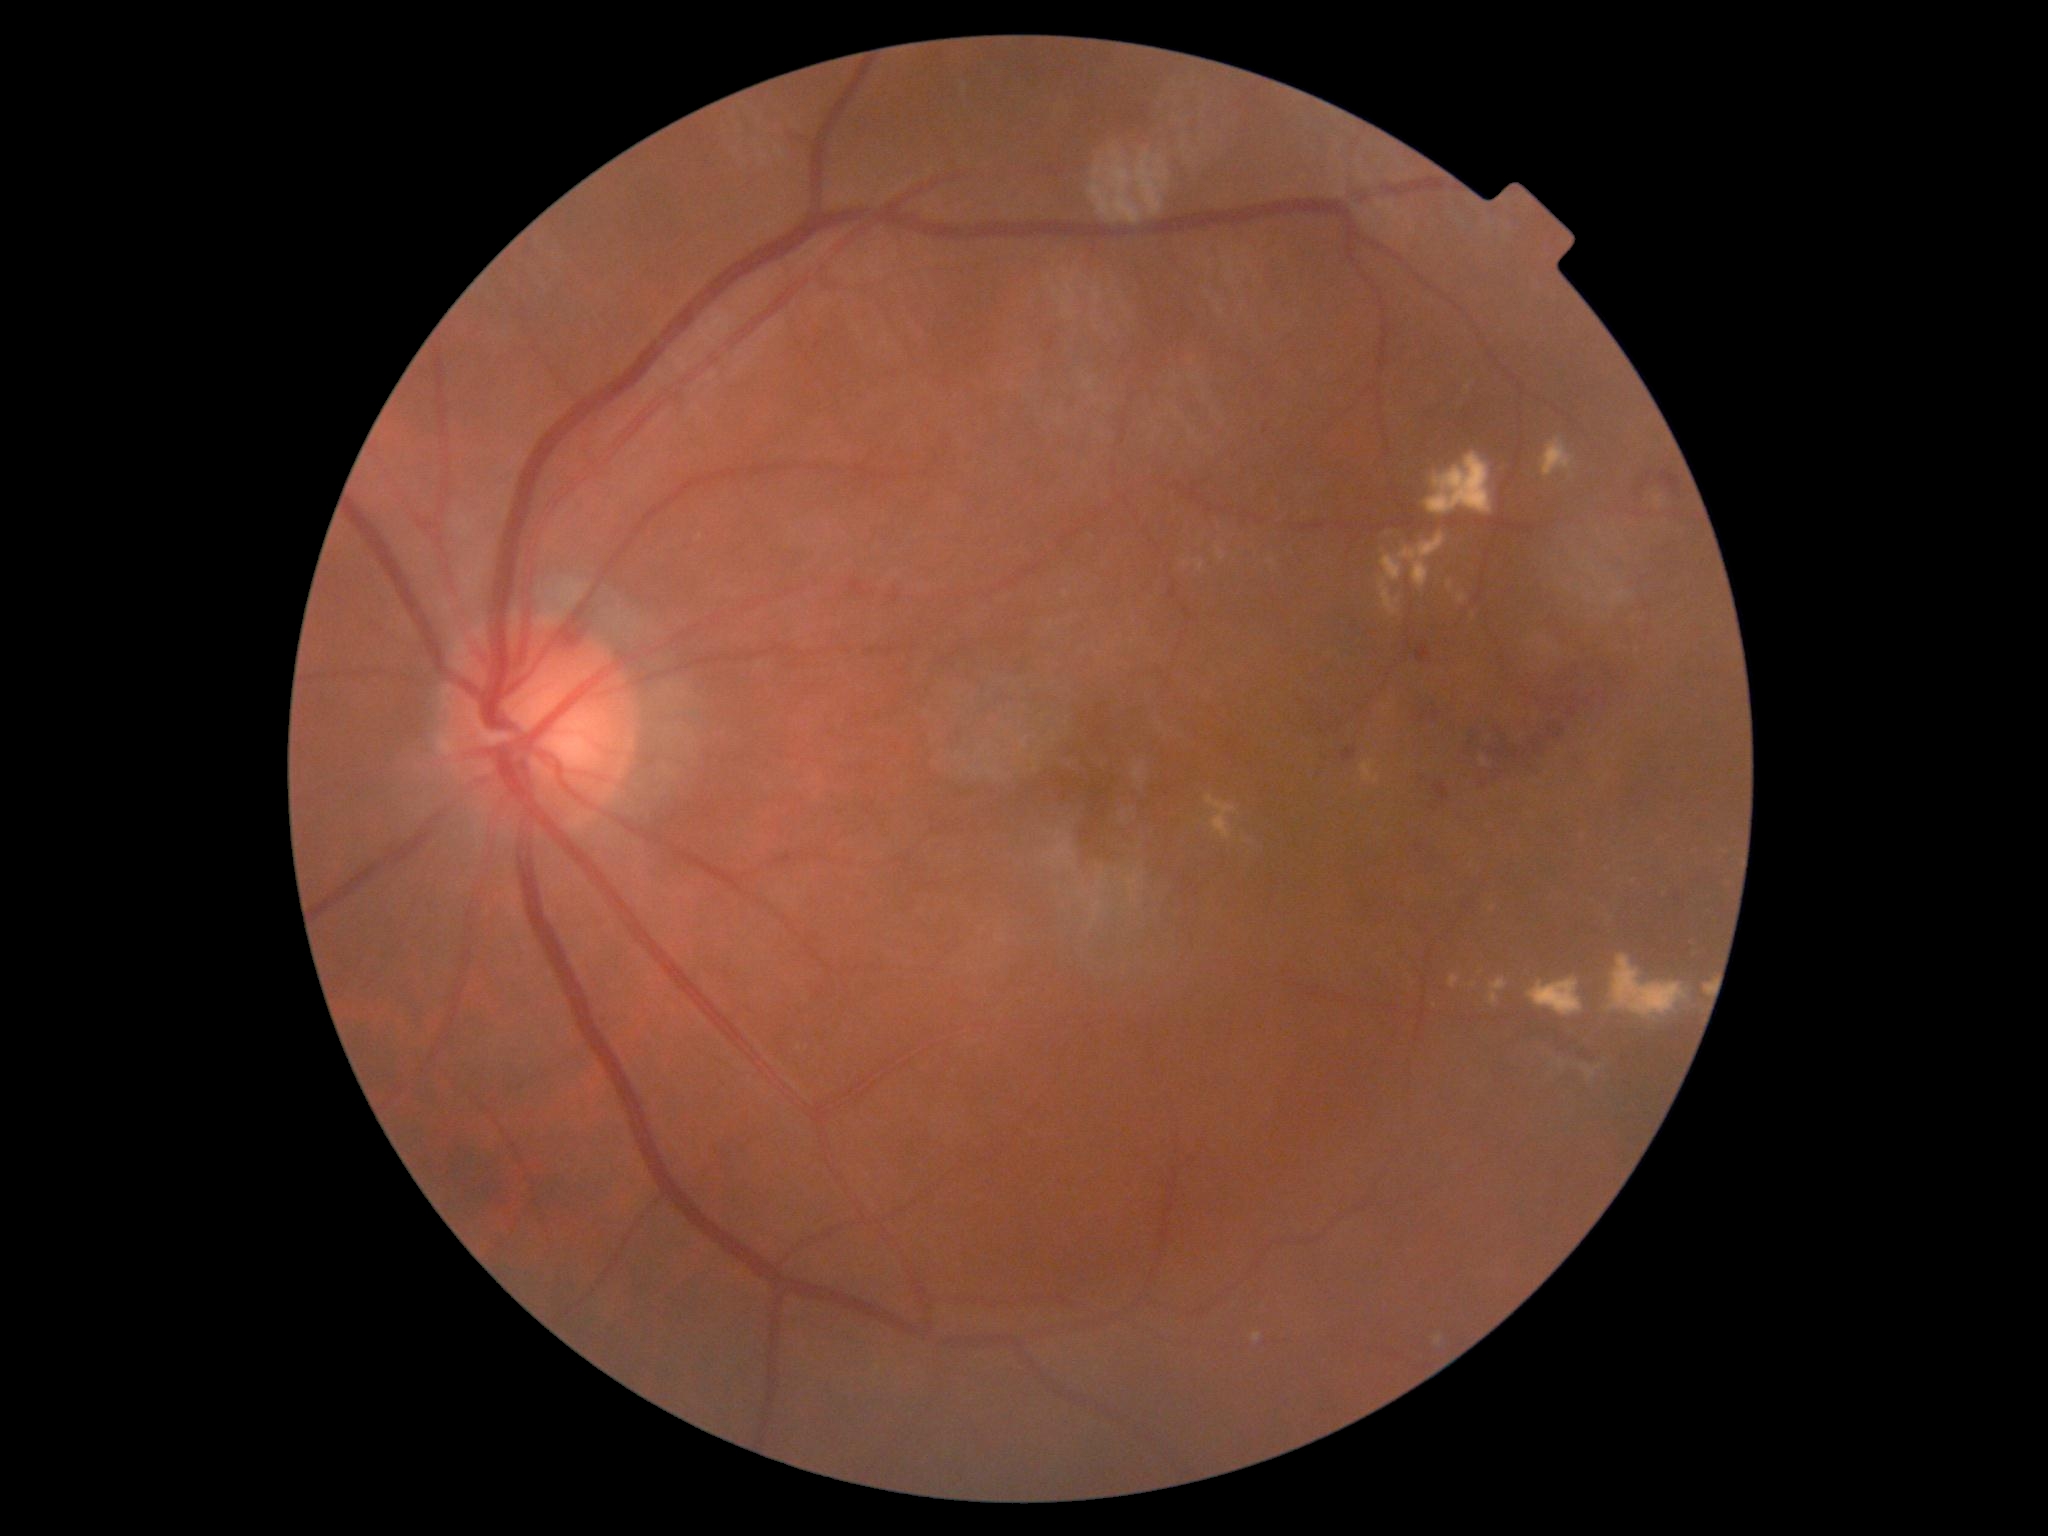 DR = grade 2 (moderate NPDR) — more than just microaneurysms but less than severe NPDR.